45° FOV · 1932x1932 · CFP.
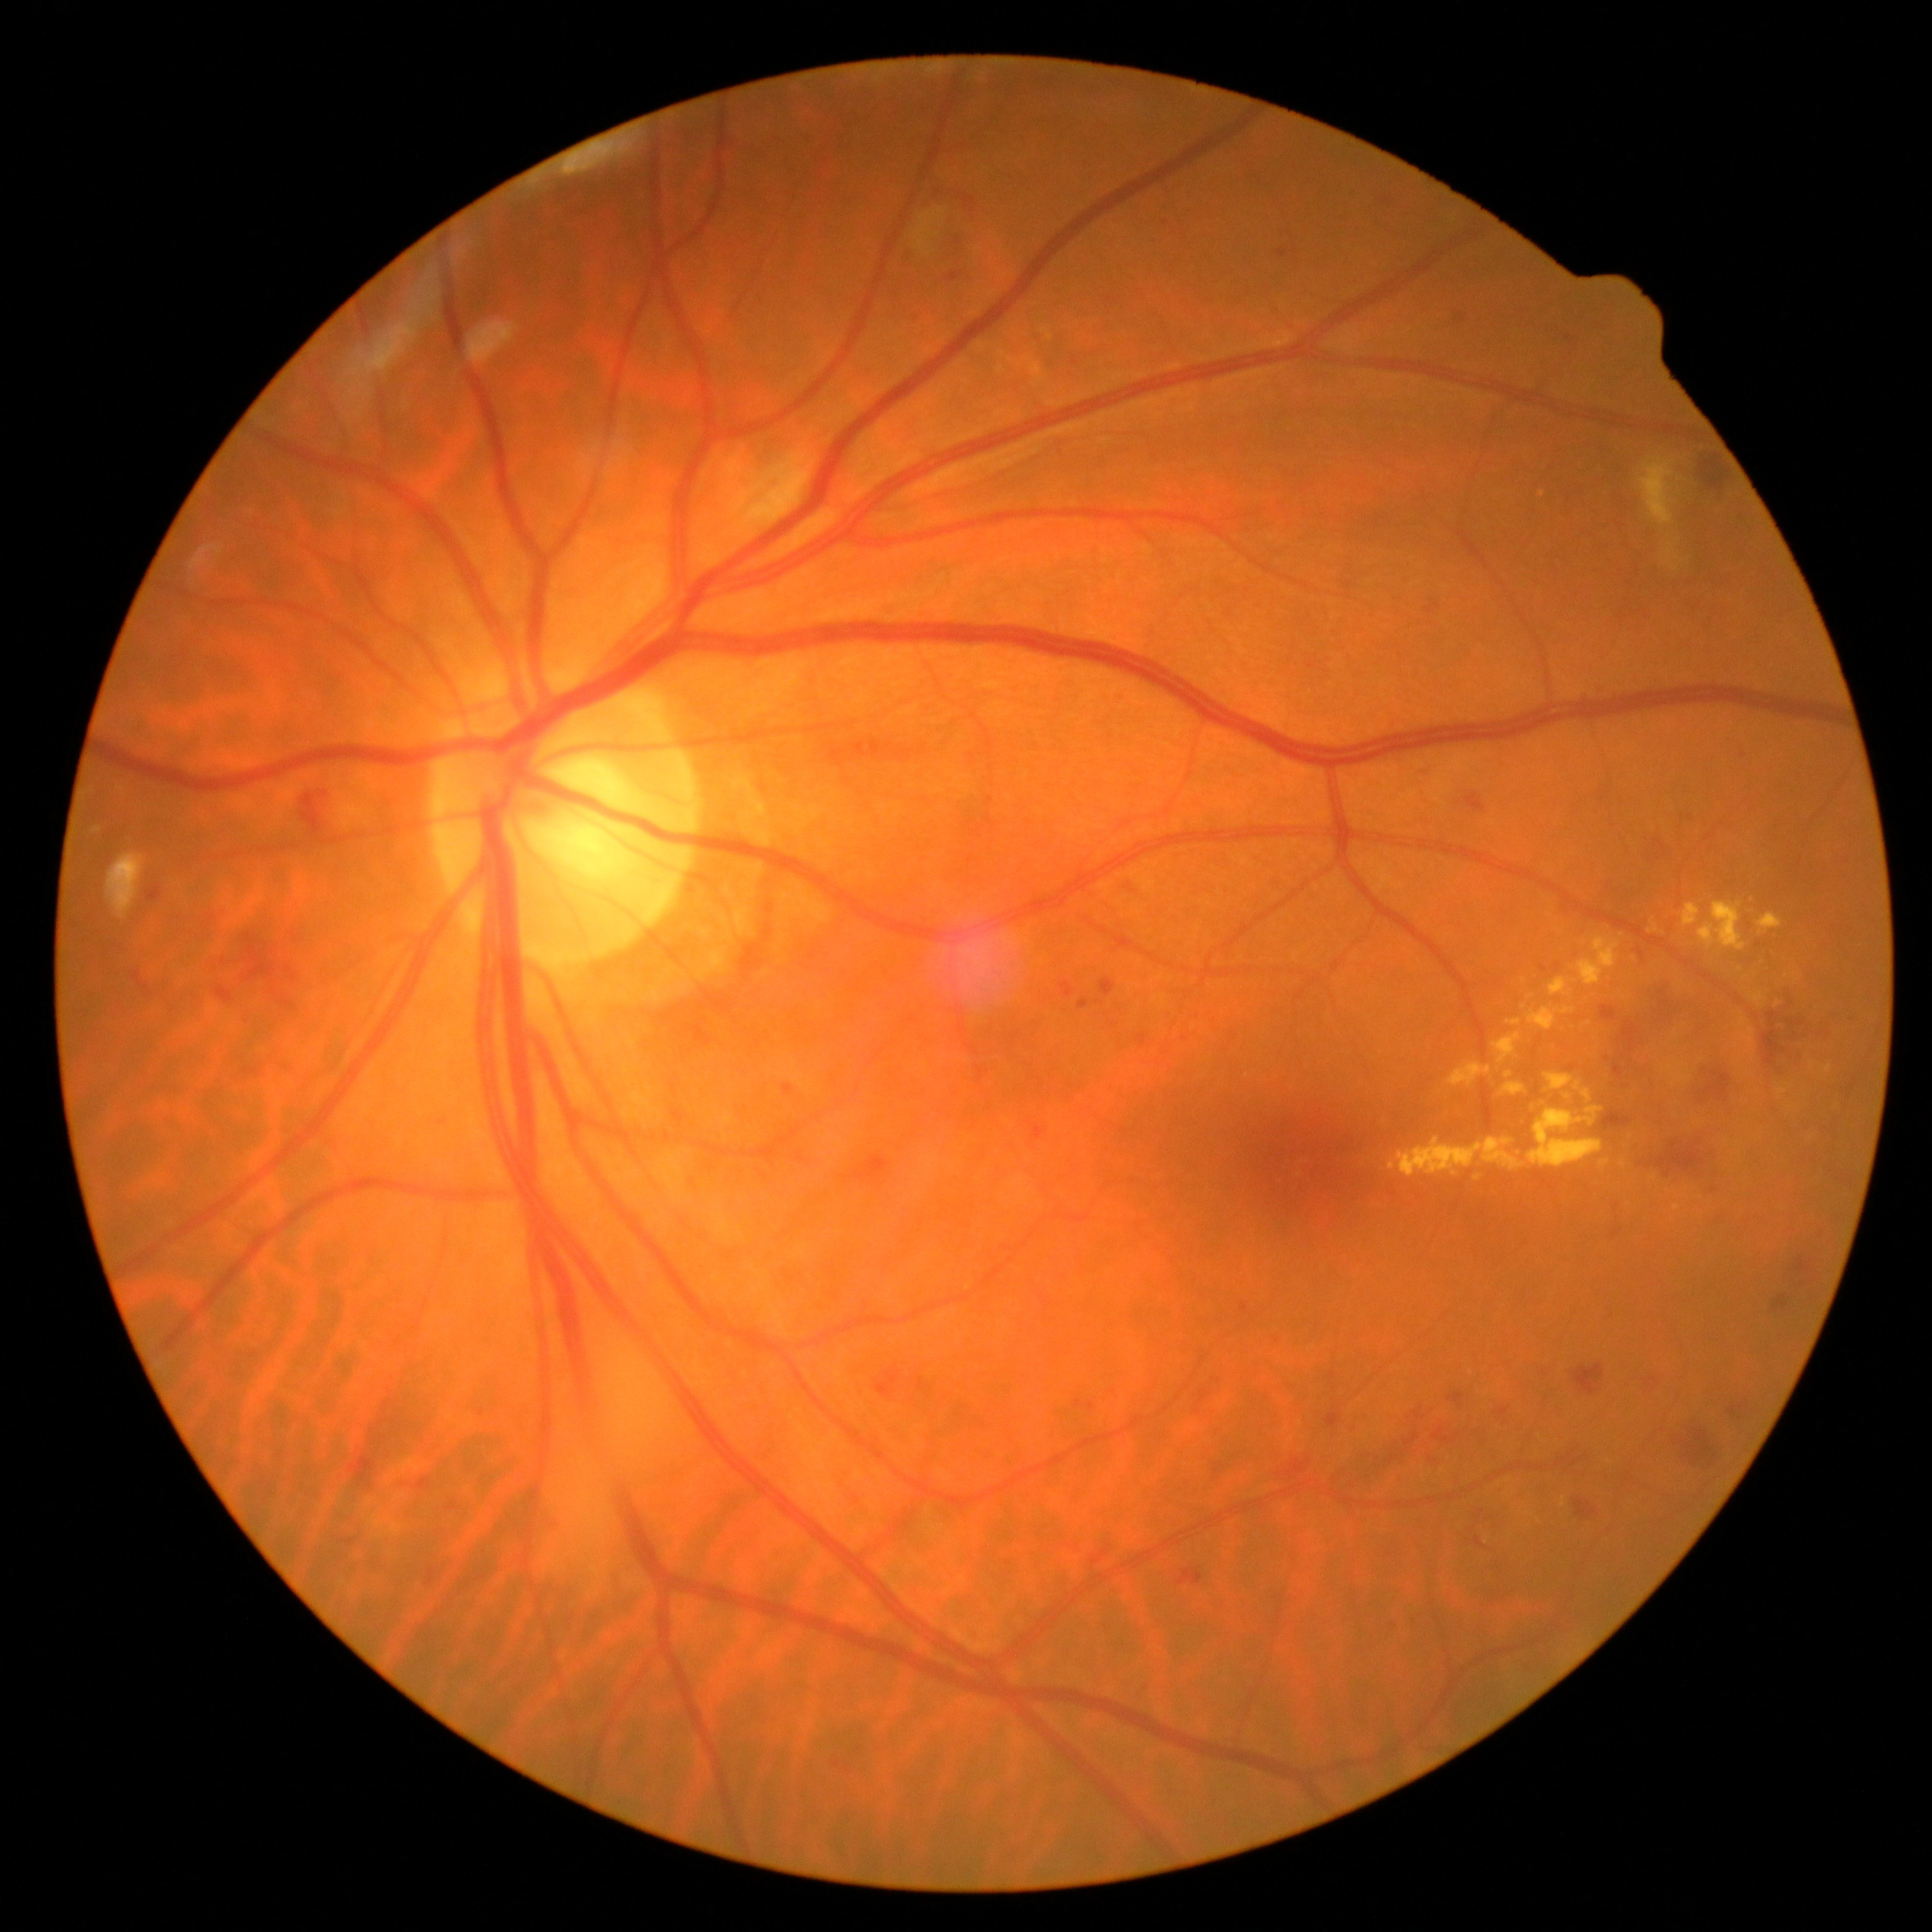
DR severity: grade 2 (moderate NPDR).